848x848px · Davis DR grading:
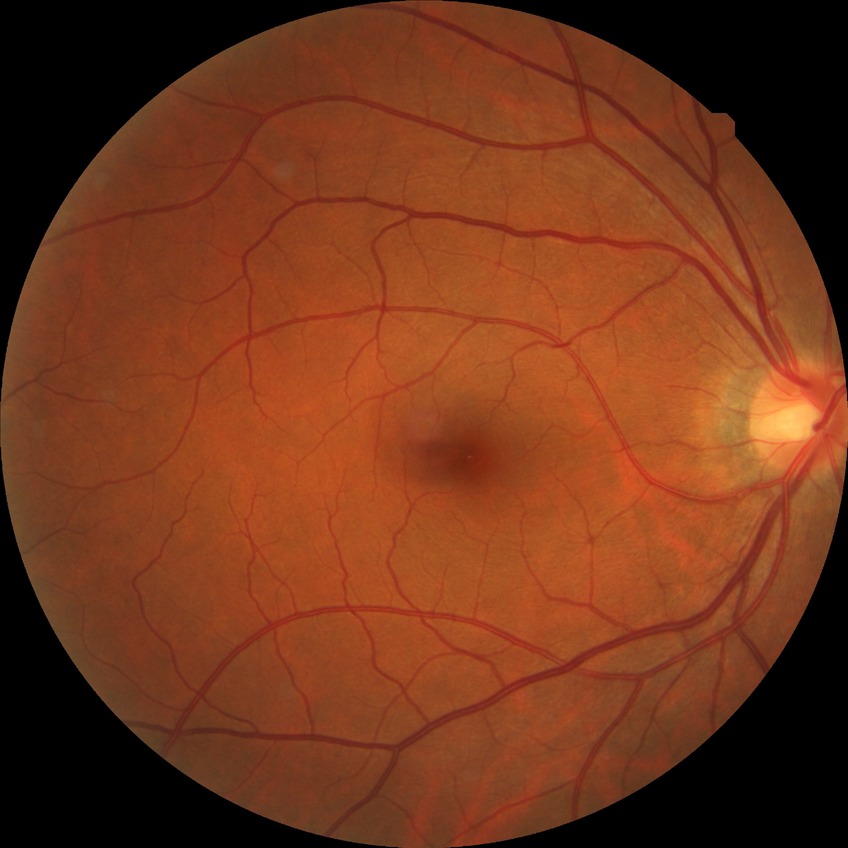
Diabetic retinopathy (DR) is NDR (no diabetic retinopathy).